Posterior pole photograph. Without pupil dilation. 848 x 848 pixels:
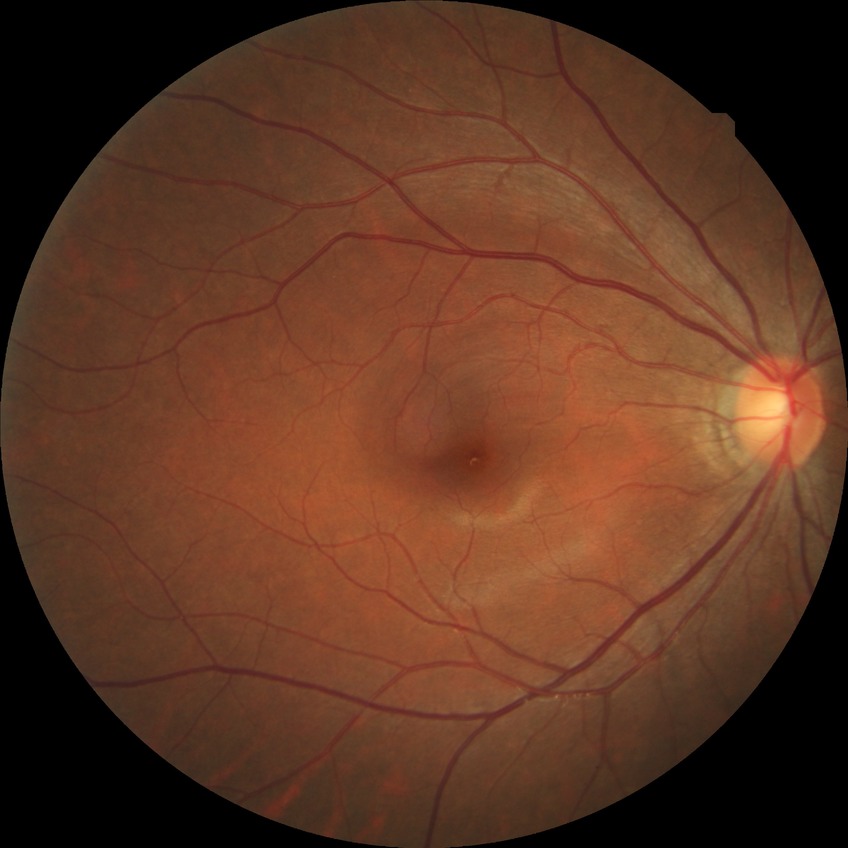 diabetic retinopathy (DR)@no diabetic retinopathy (NDR).